Color fundus photograph.
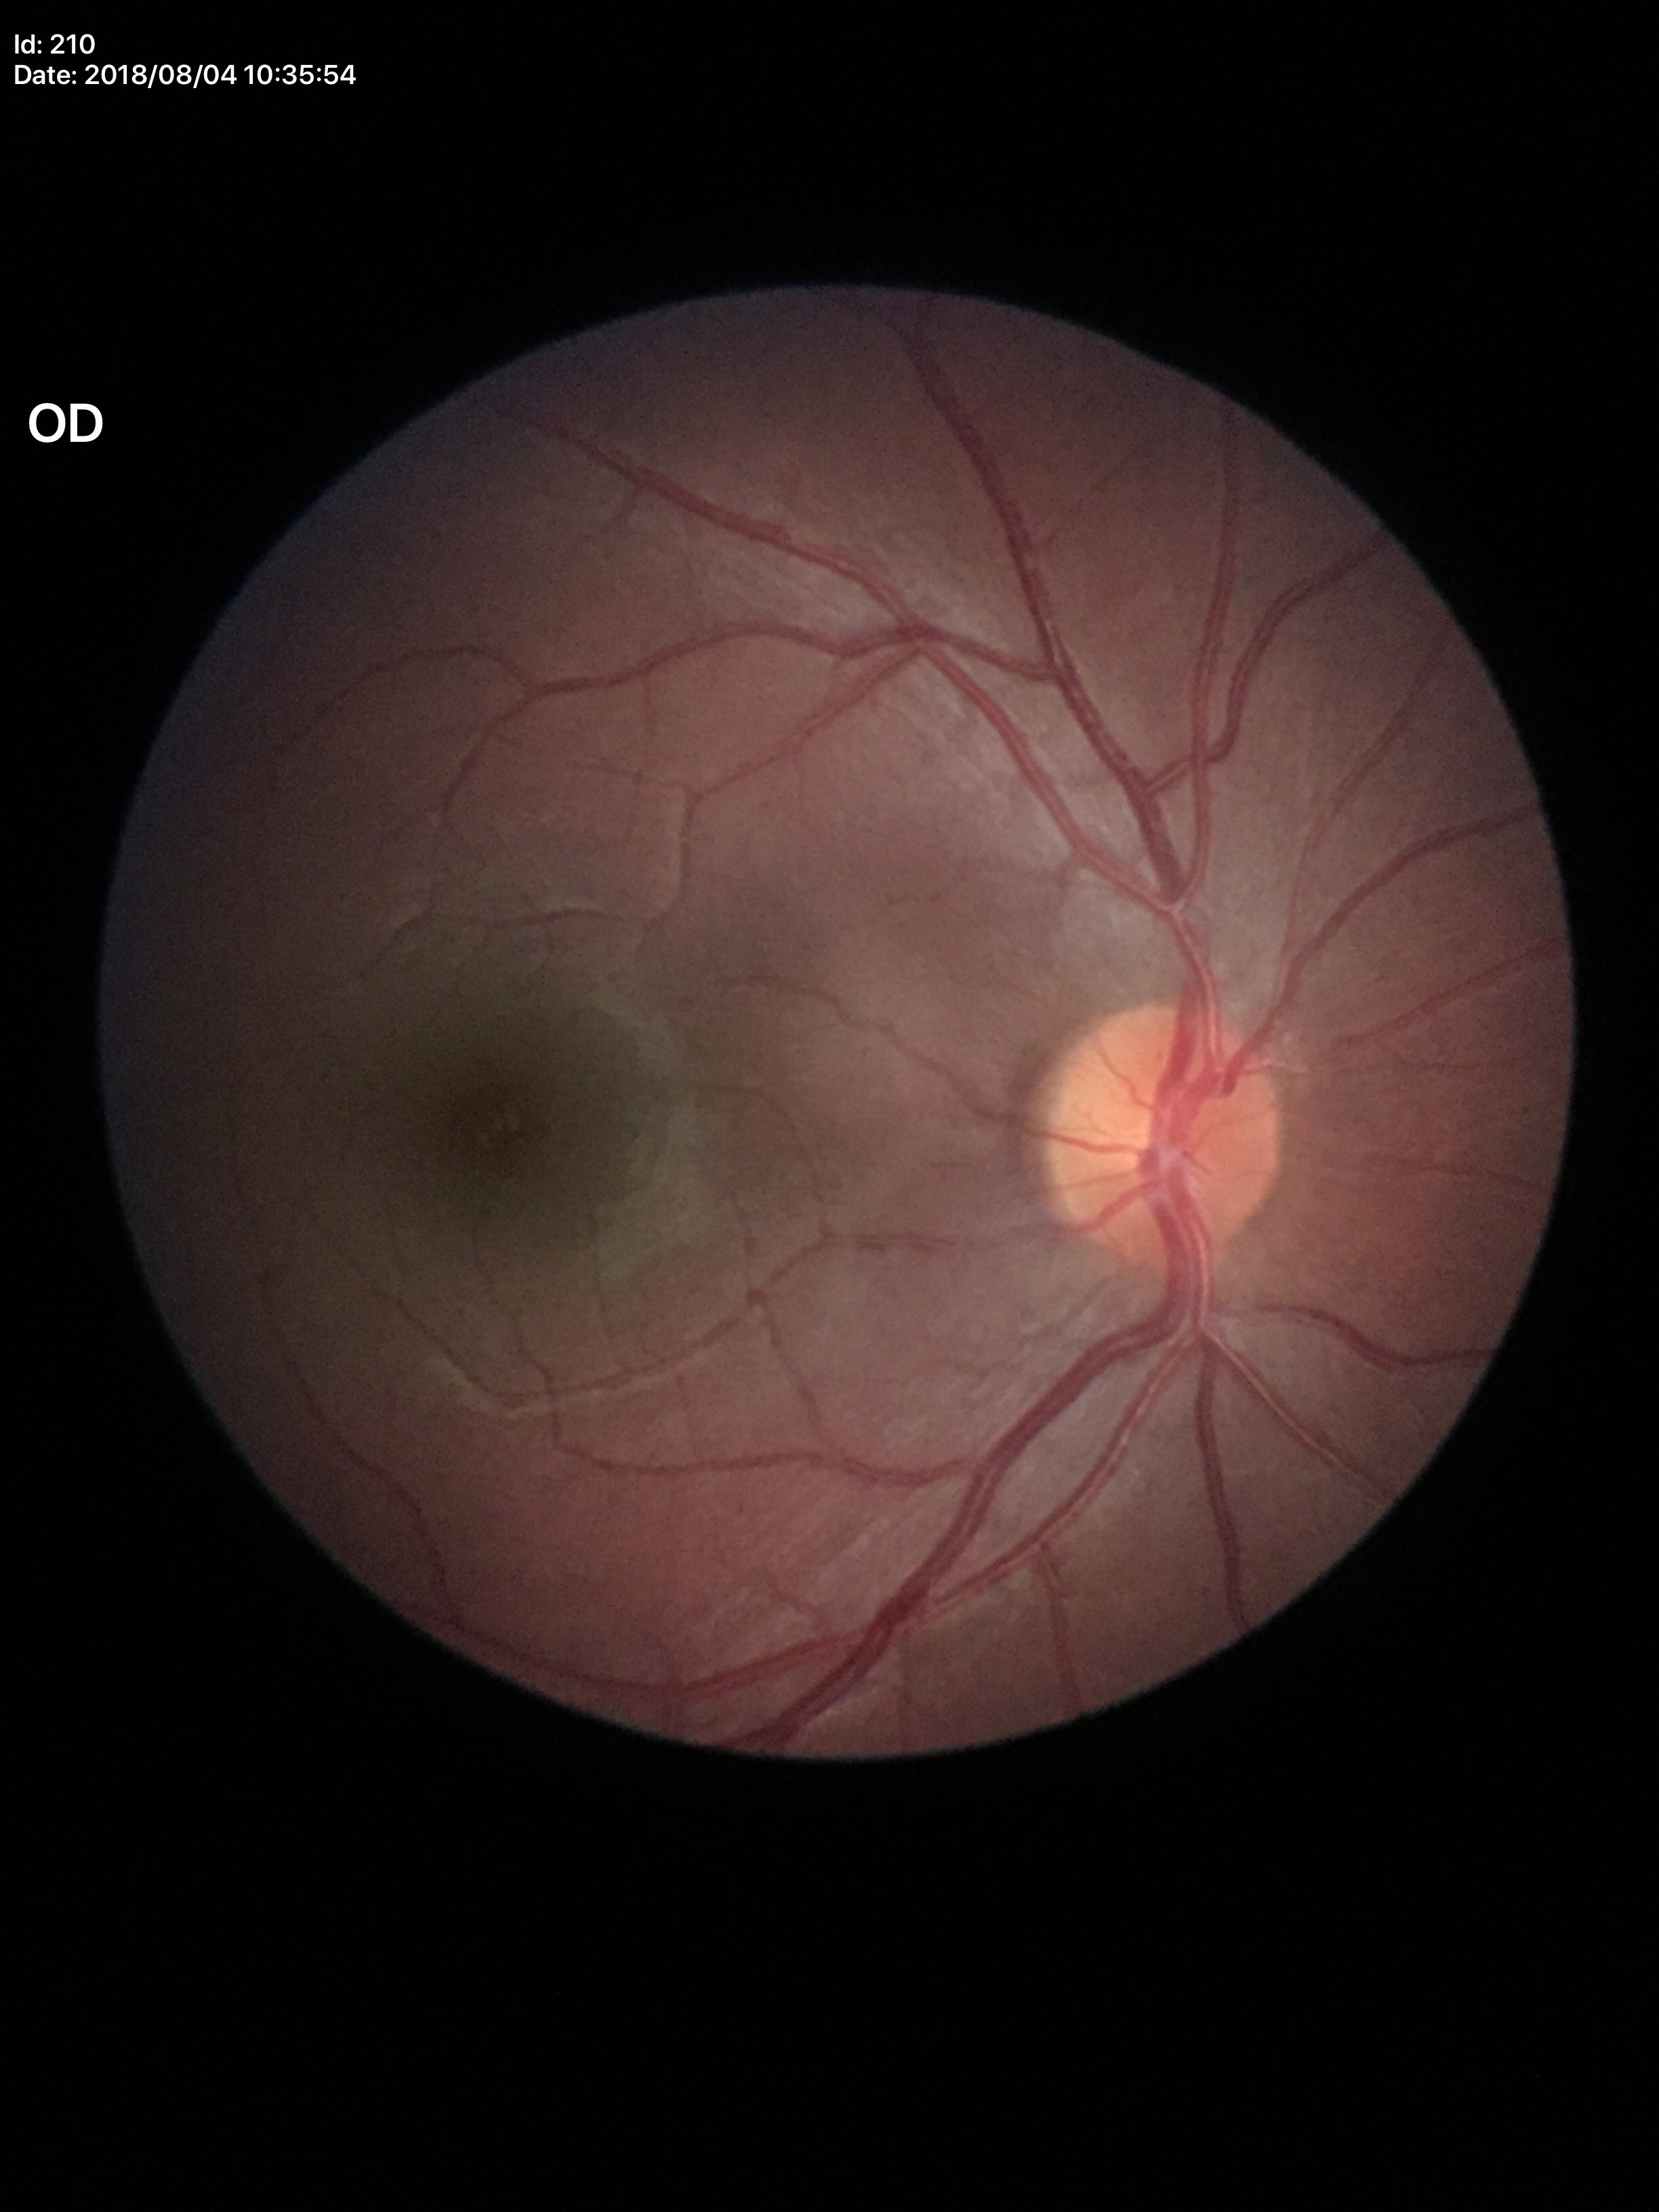

vertical C/D ratio (VCDR): 0.50; Glaucoma screening impression: not suspect.